848 x 848 pixels: 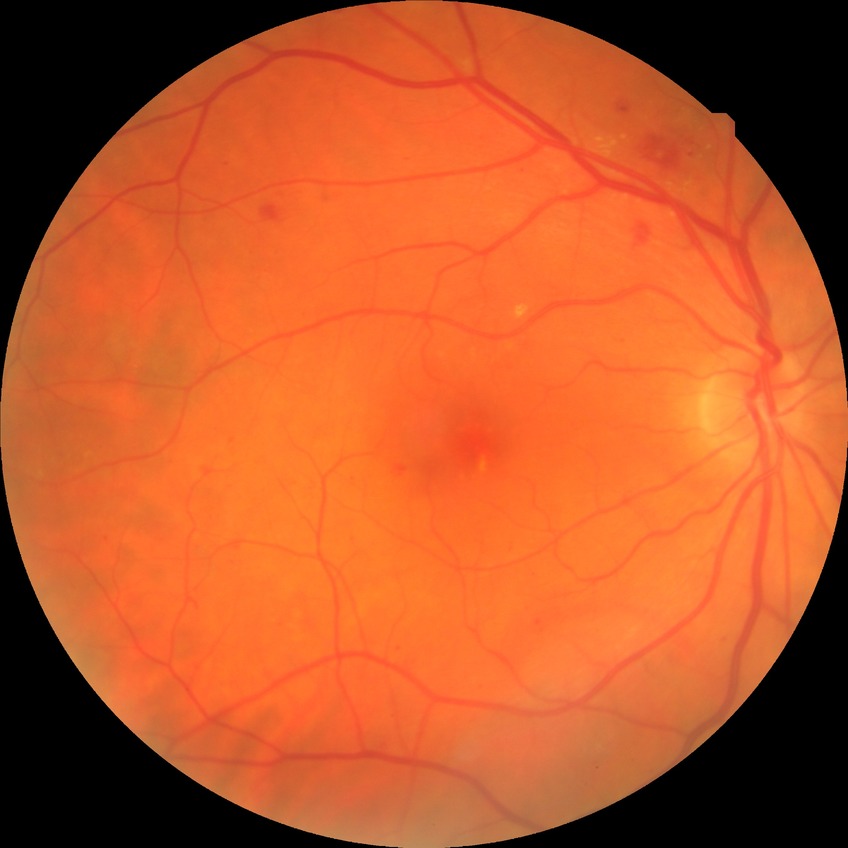
Modified Davis grading: simple diabetic retinopathy.